Pediatric wide-field fundus photograph · Clarity RetCam 3, 130° FOV — 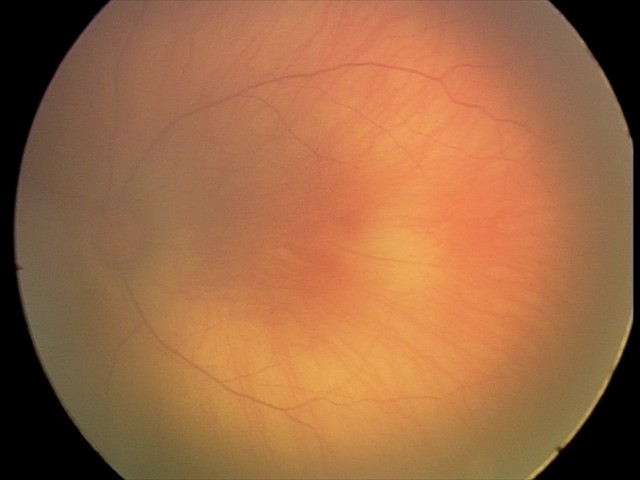 Diagnosis from this screening exam: retinal hemorrhages.